Retinal fundus photograph — 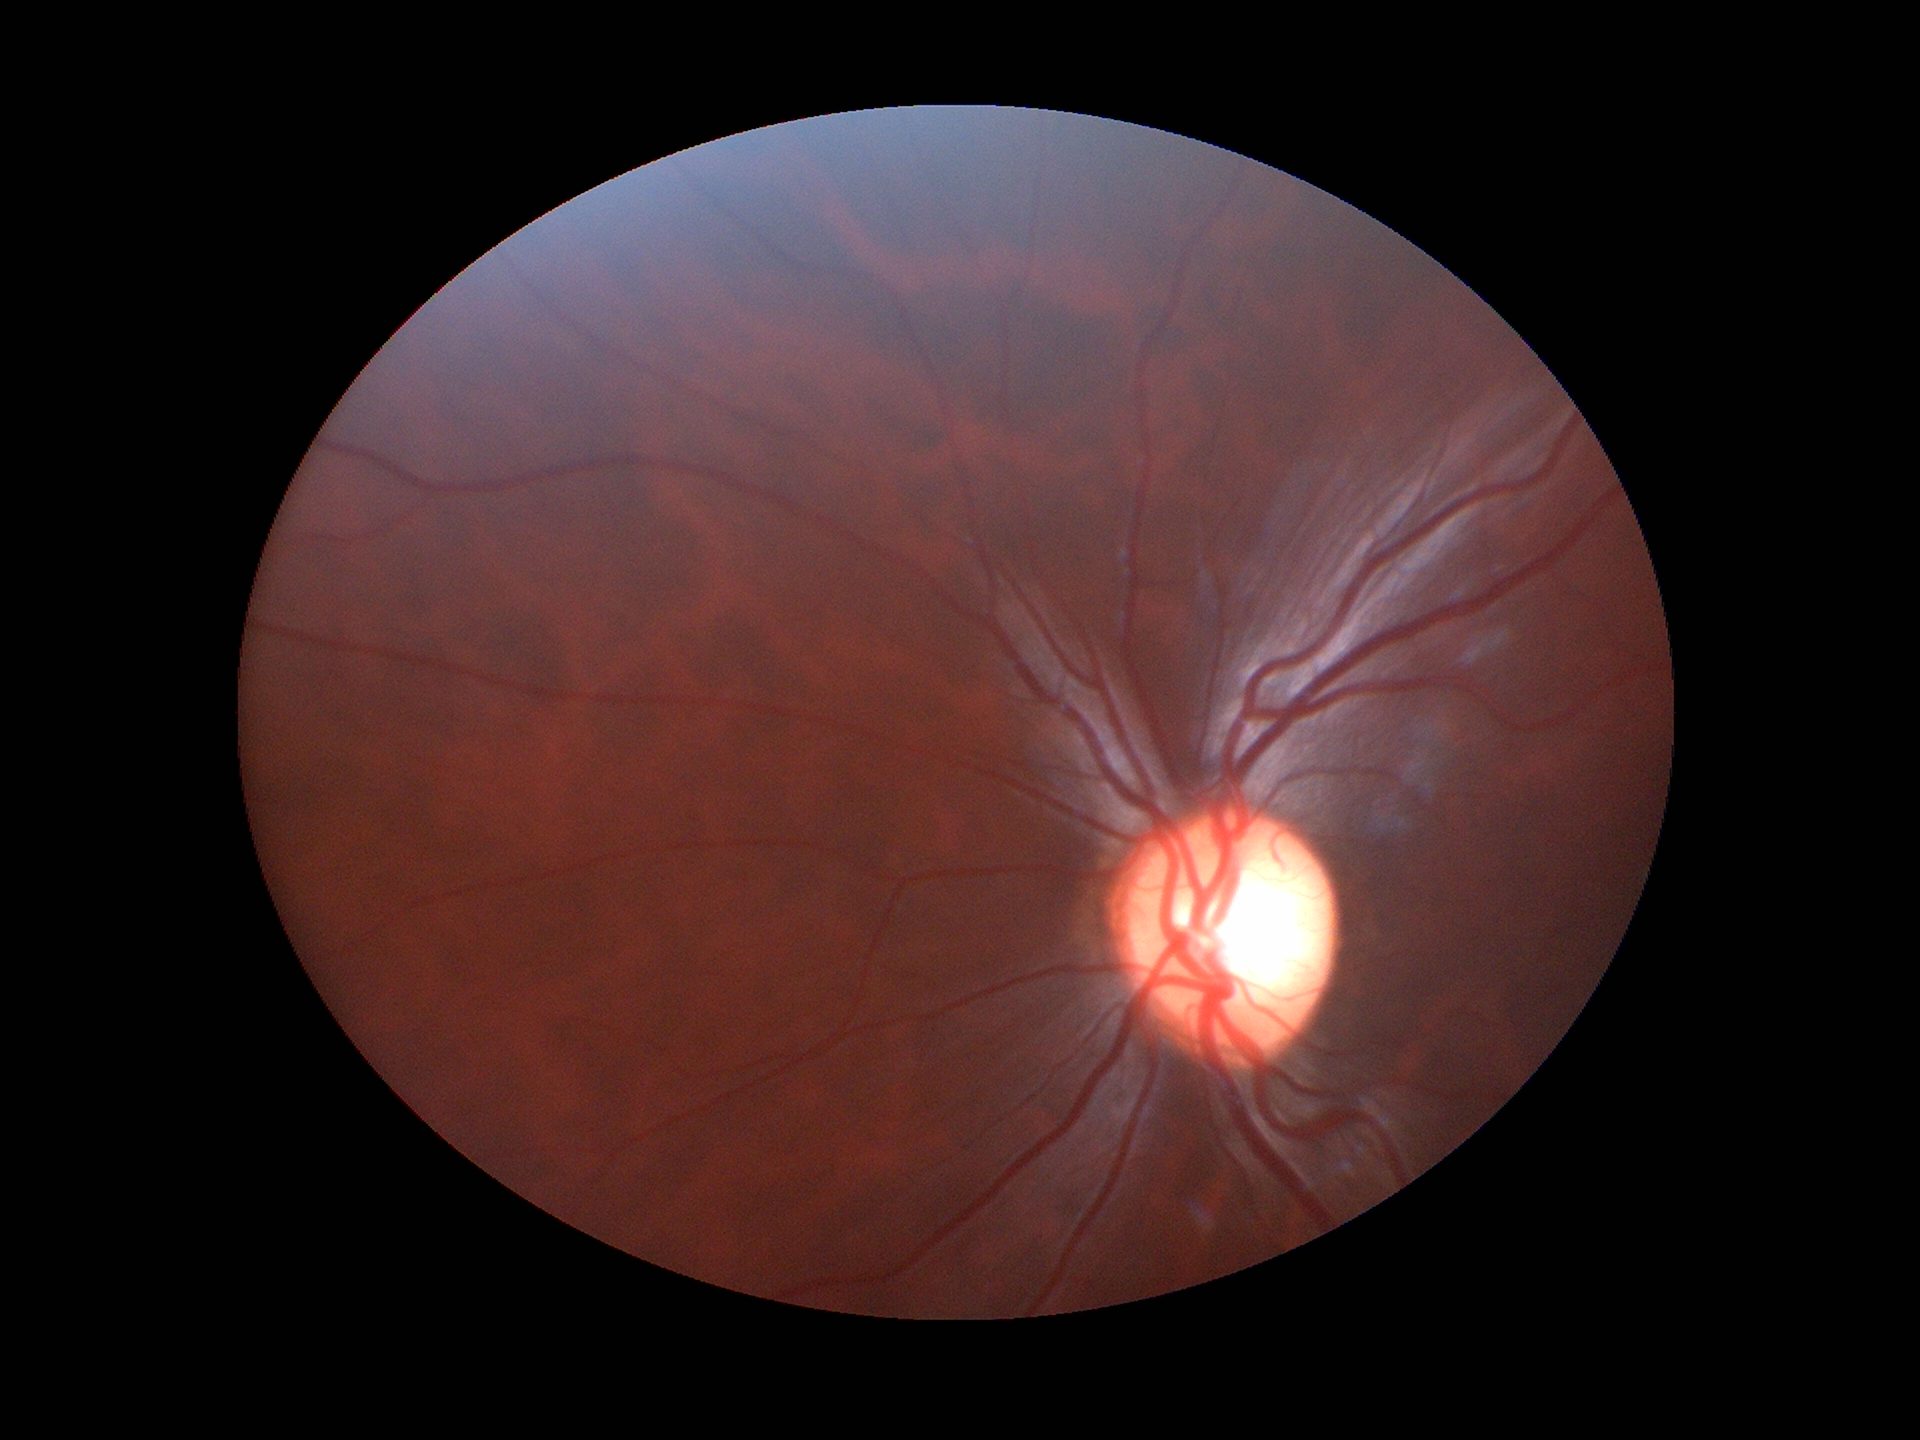 Glaucoma impression: suspicious (3 of 5 graders flagged glaucoma suspect). Vertical cup-to-disc ratio (VCDR) of 0.60.